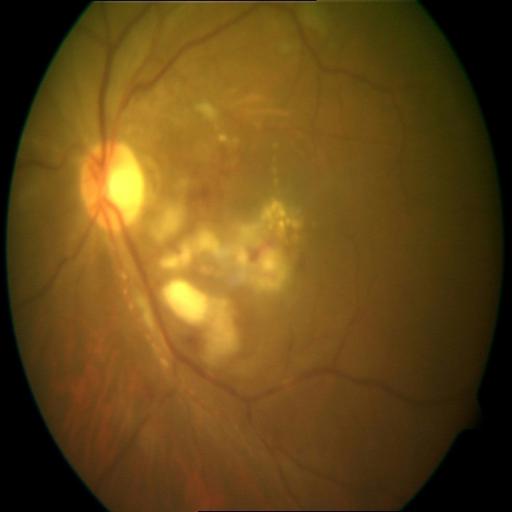 There is evidence of retinitis.